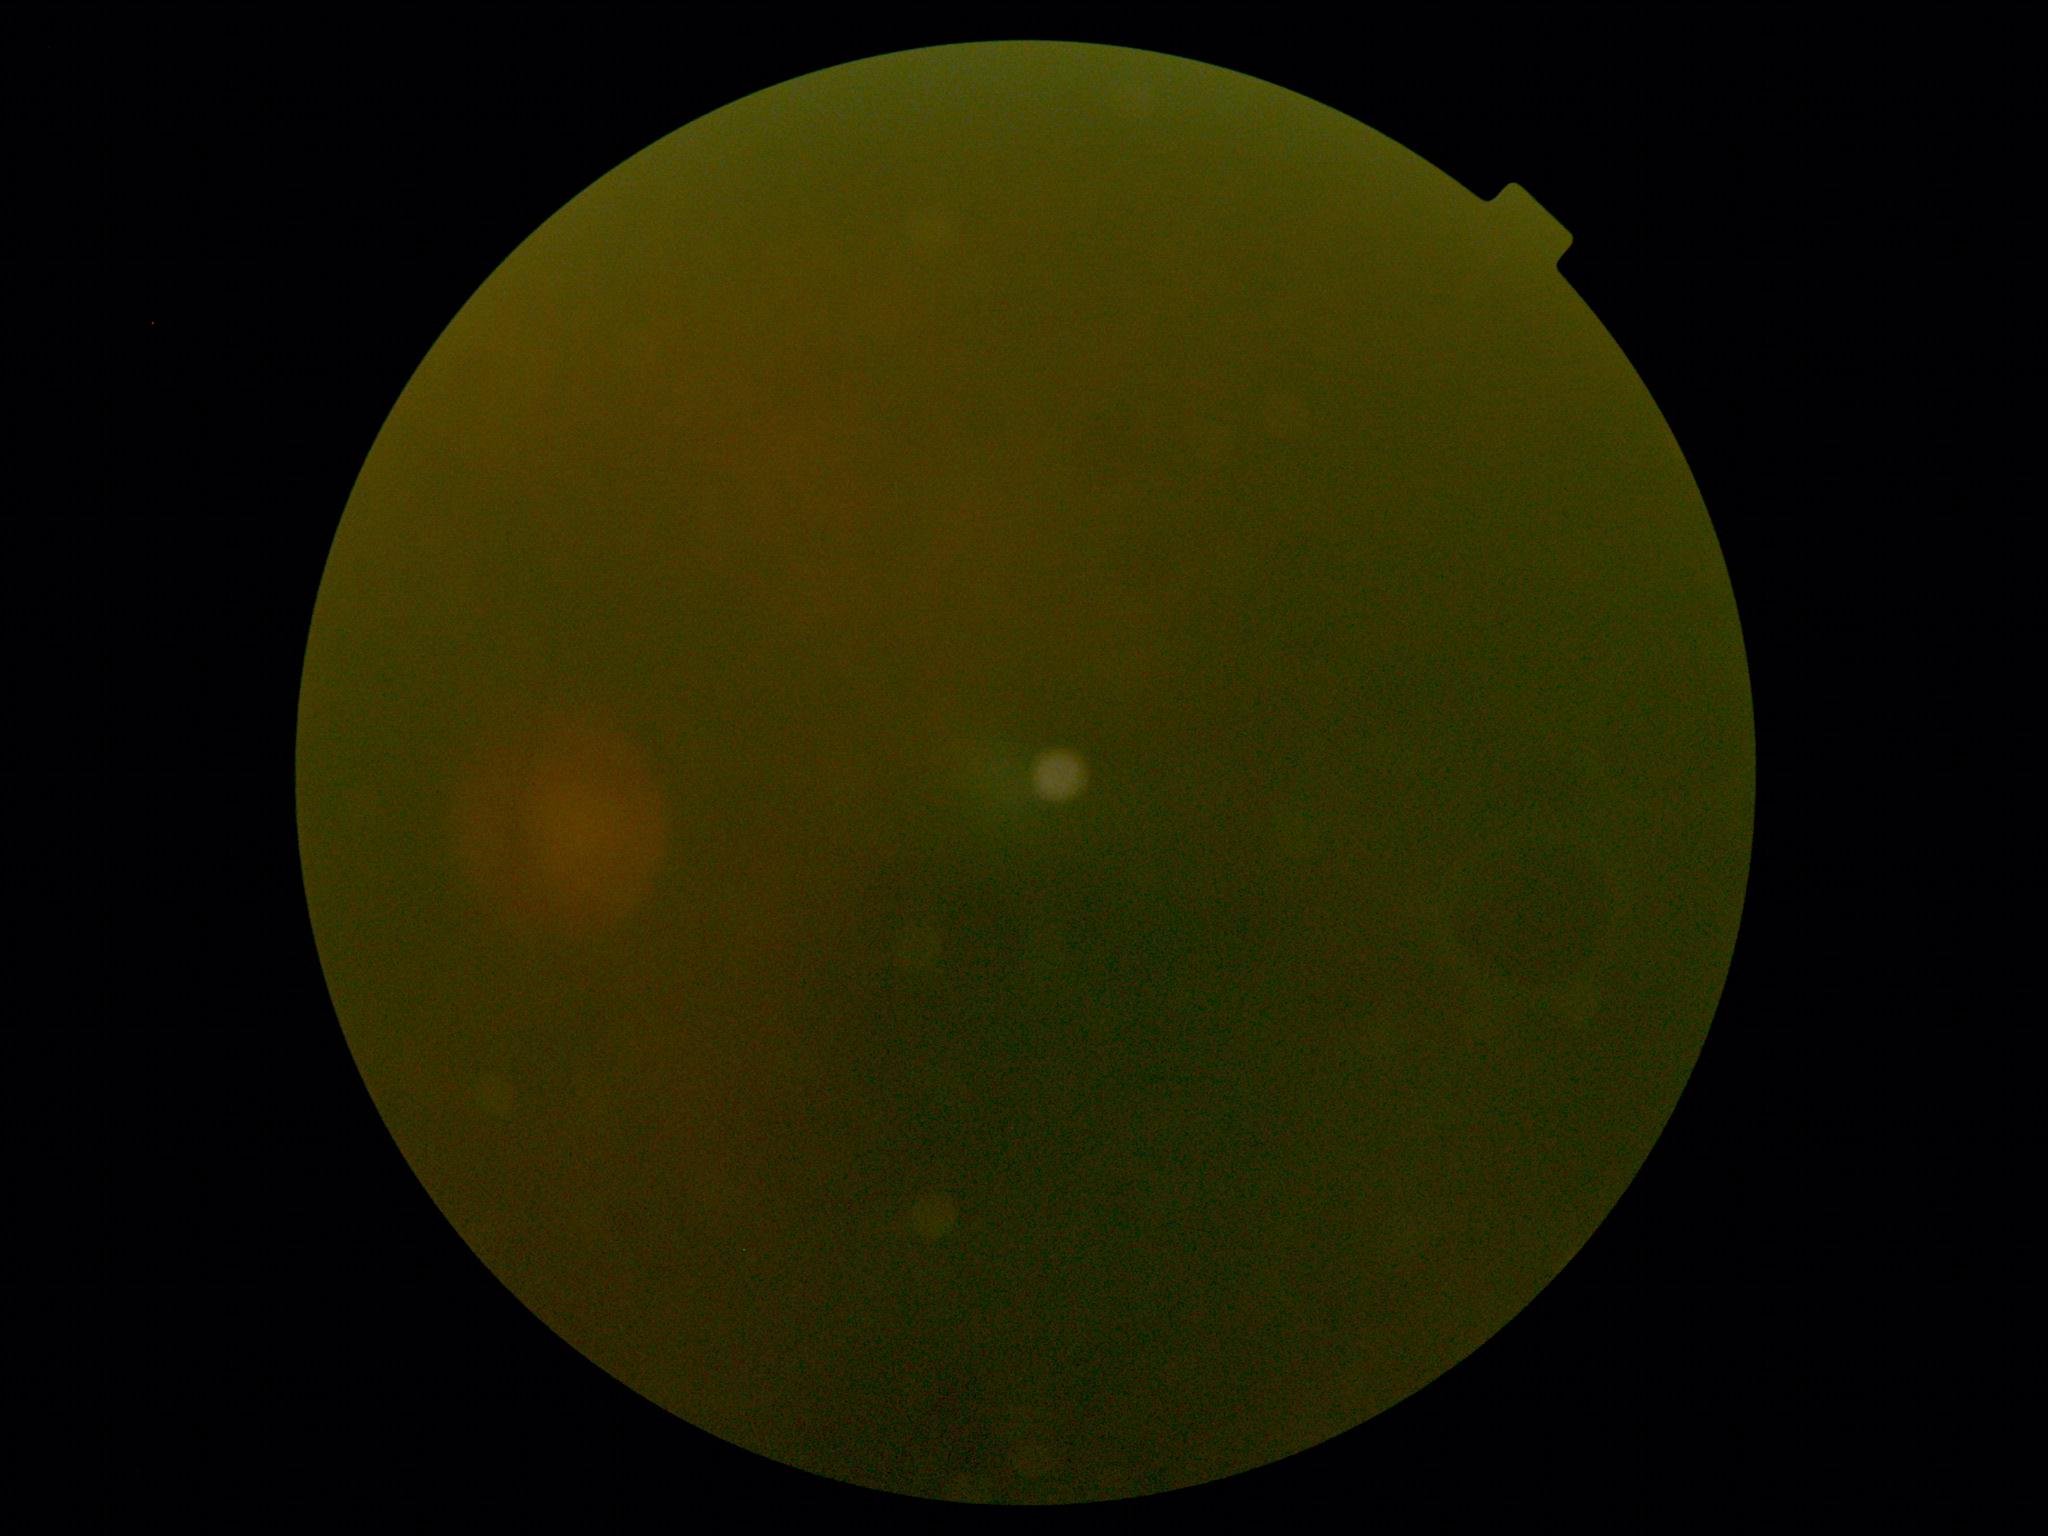

retinopathy@ungradable due to poor image quality, image quality@insufficient.